DR severity per modified Davis staging. 45 degree fundus photograph:
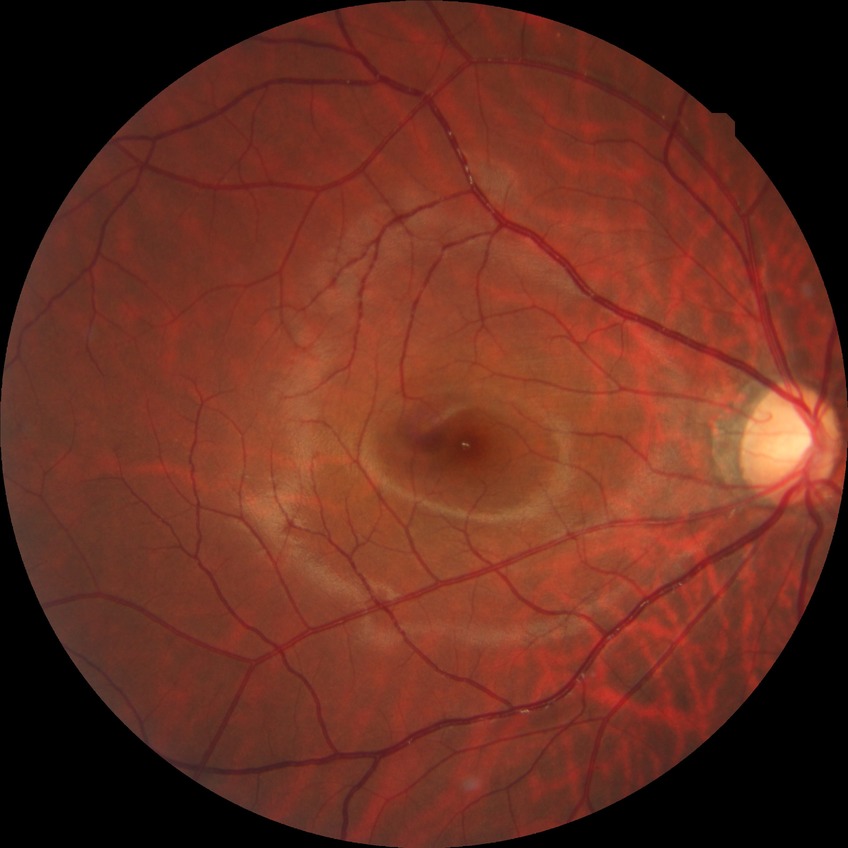
diabetic retinopathy (DR)@NDR (no diabetic retinopathy).